1920x1440px
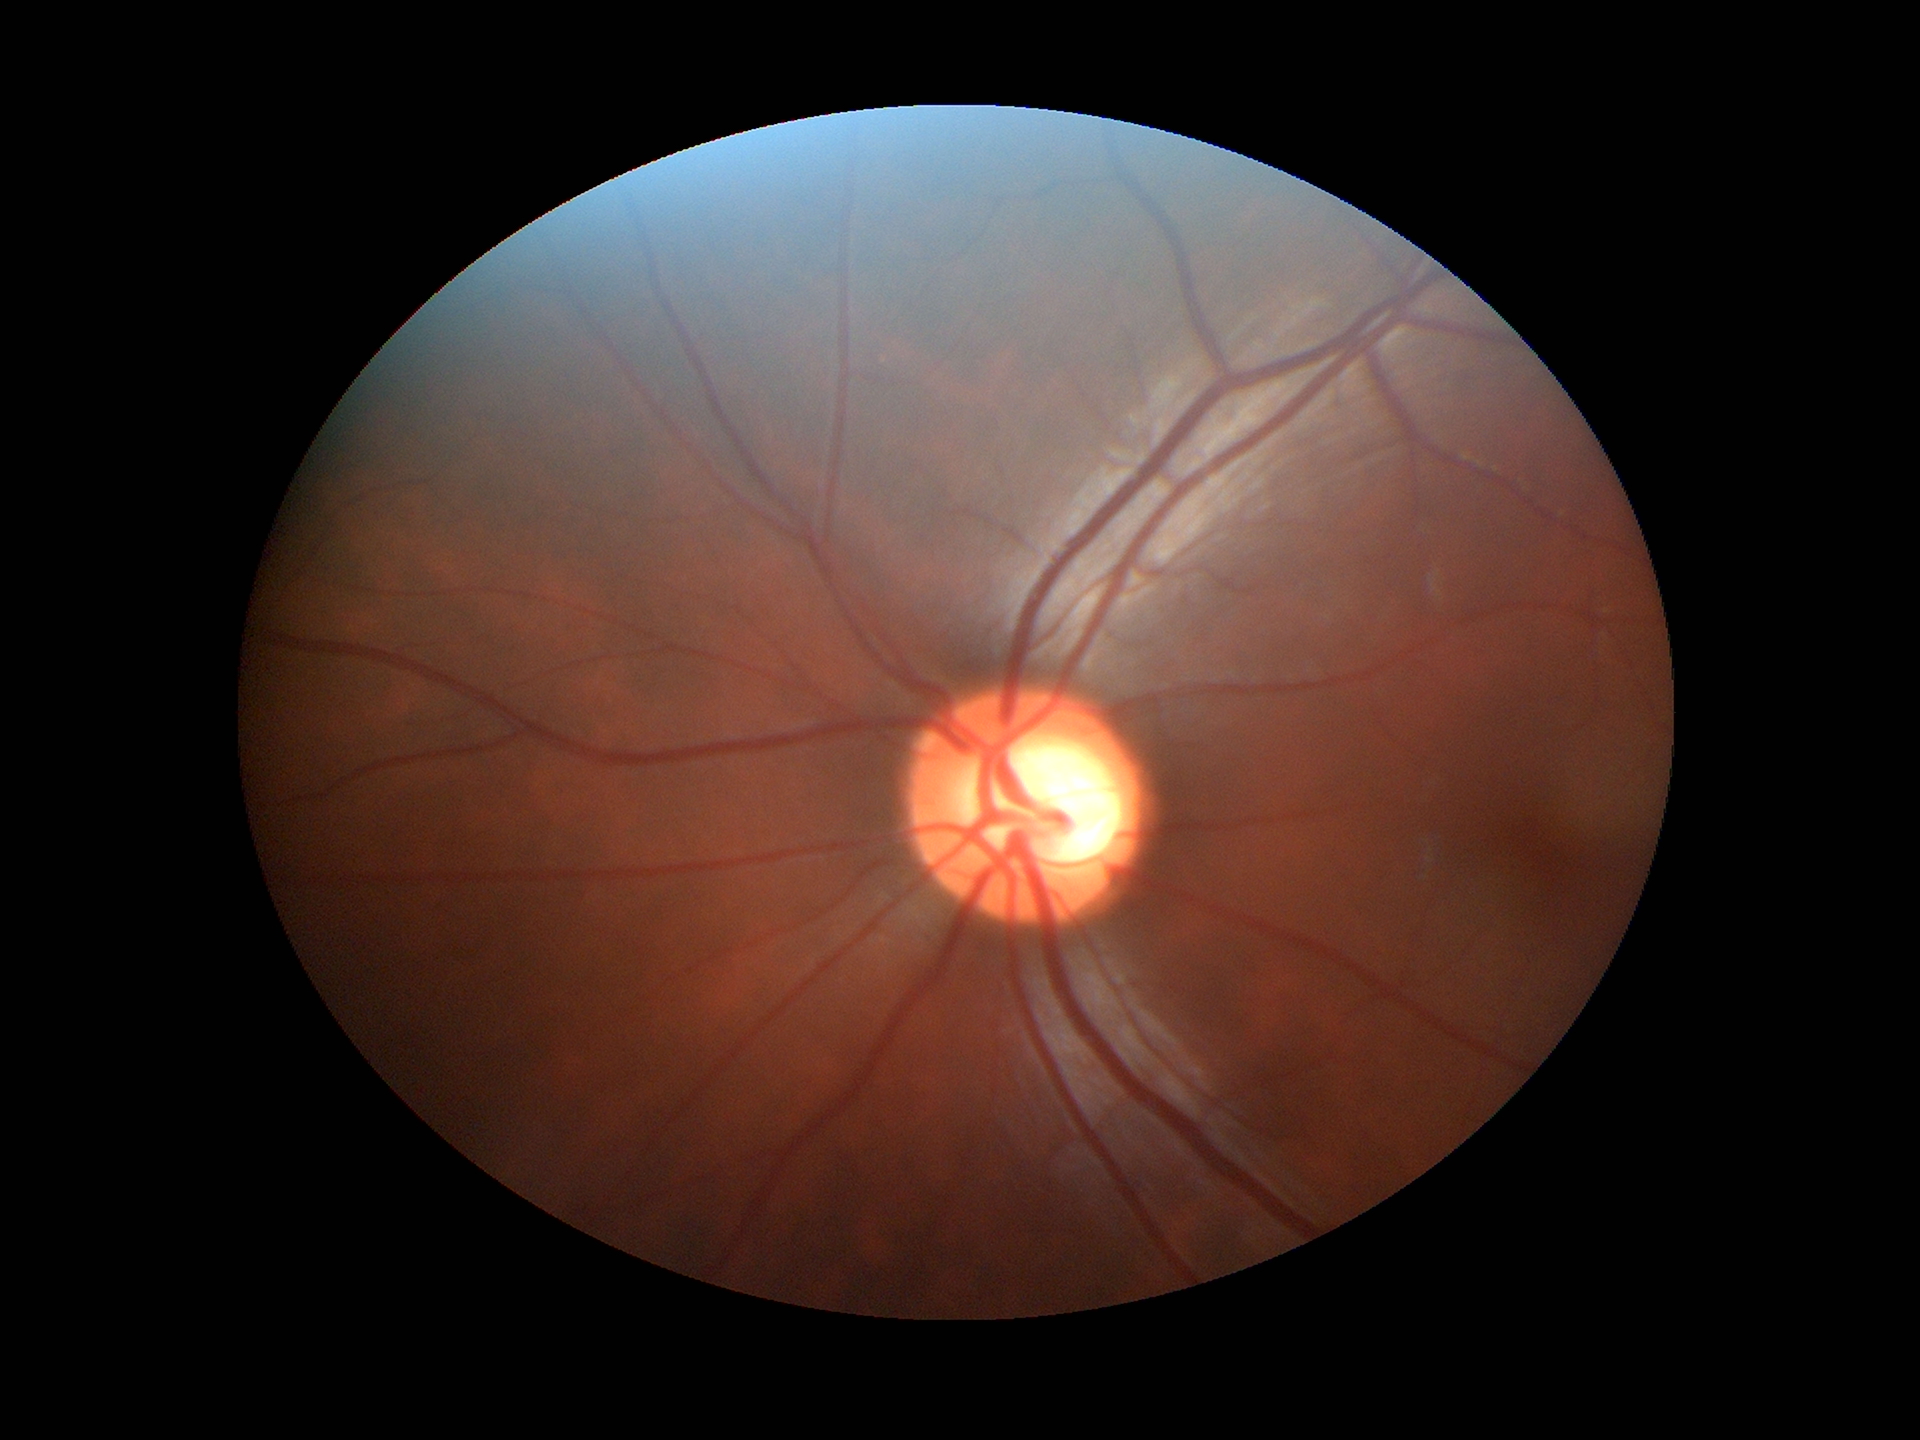
Glaucoma impression = suspicious findings; vertical CDR = 0.61.